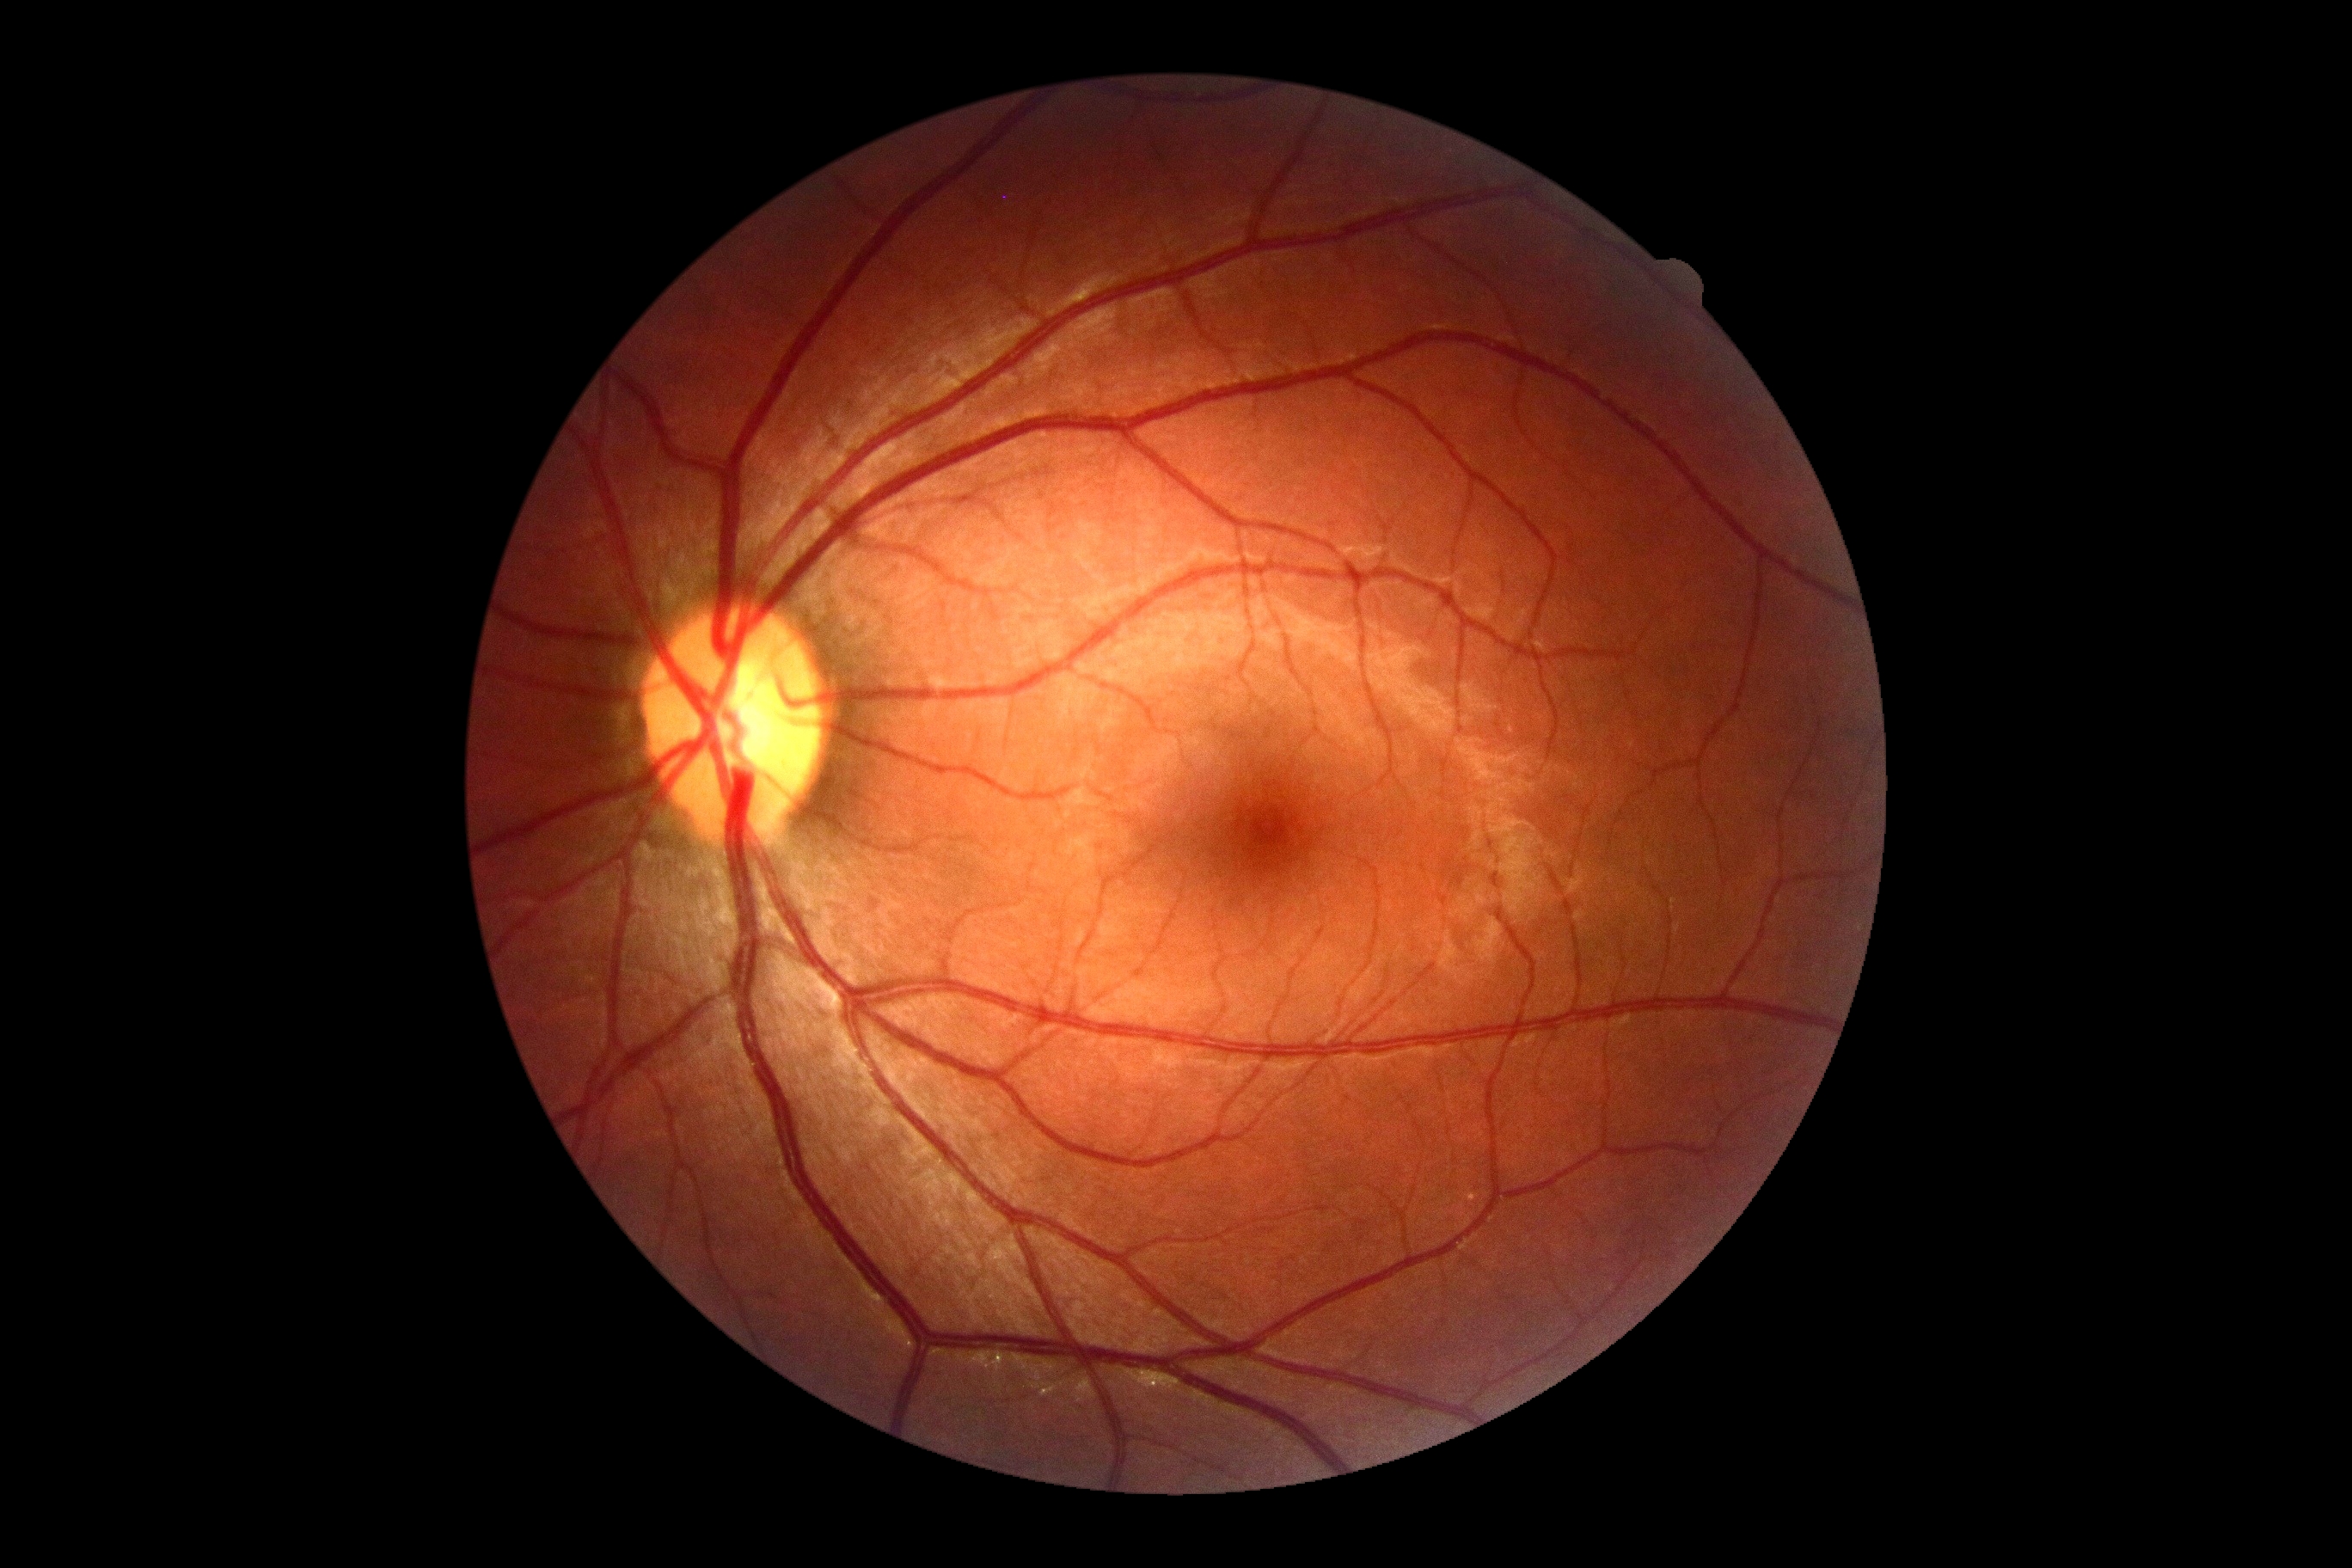

{"dr_impression": "no DR findings", "dr_grade": "0"}